NIDEK AFC-230: 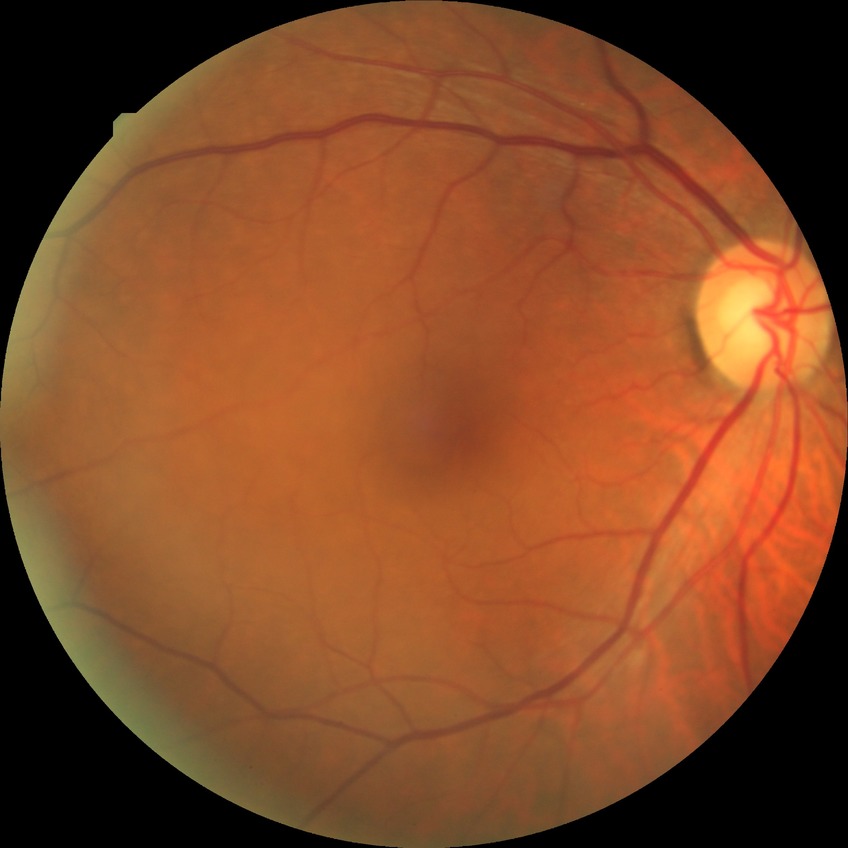
Findings:
* Davis grading — no diabetic retinopathy